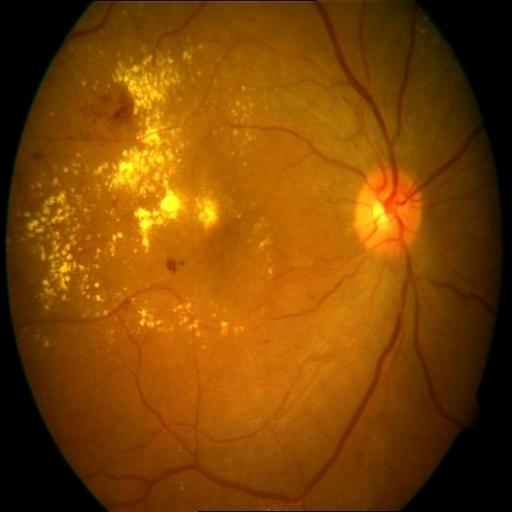
Findings (3): cystoid macular edema | exudation | hemorrhagic retinopathy.